Modified Davis grading.
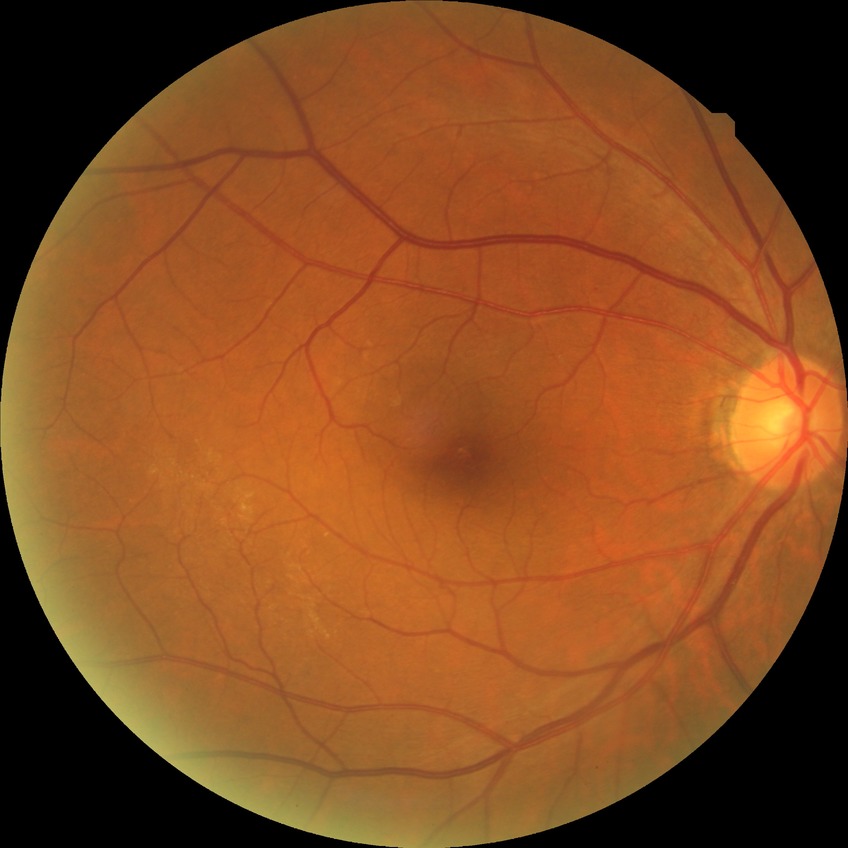 diabetic retinopathy (DR): no diabetic retinopathy (NDR).